1924x1556px. 200° field of view. UWF retinal mosaic.
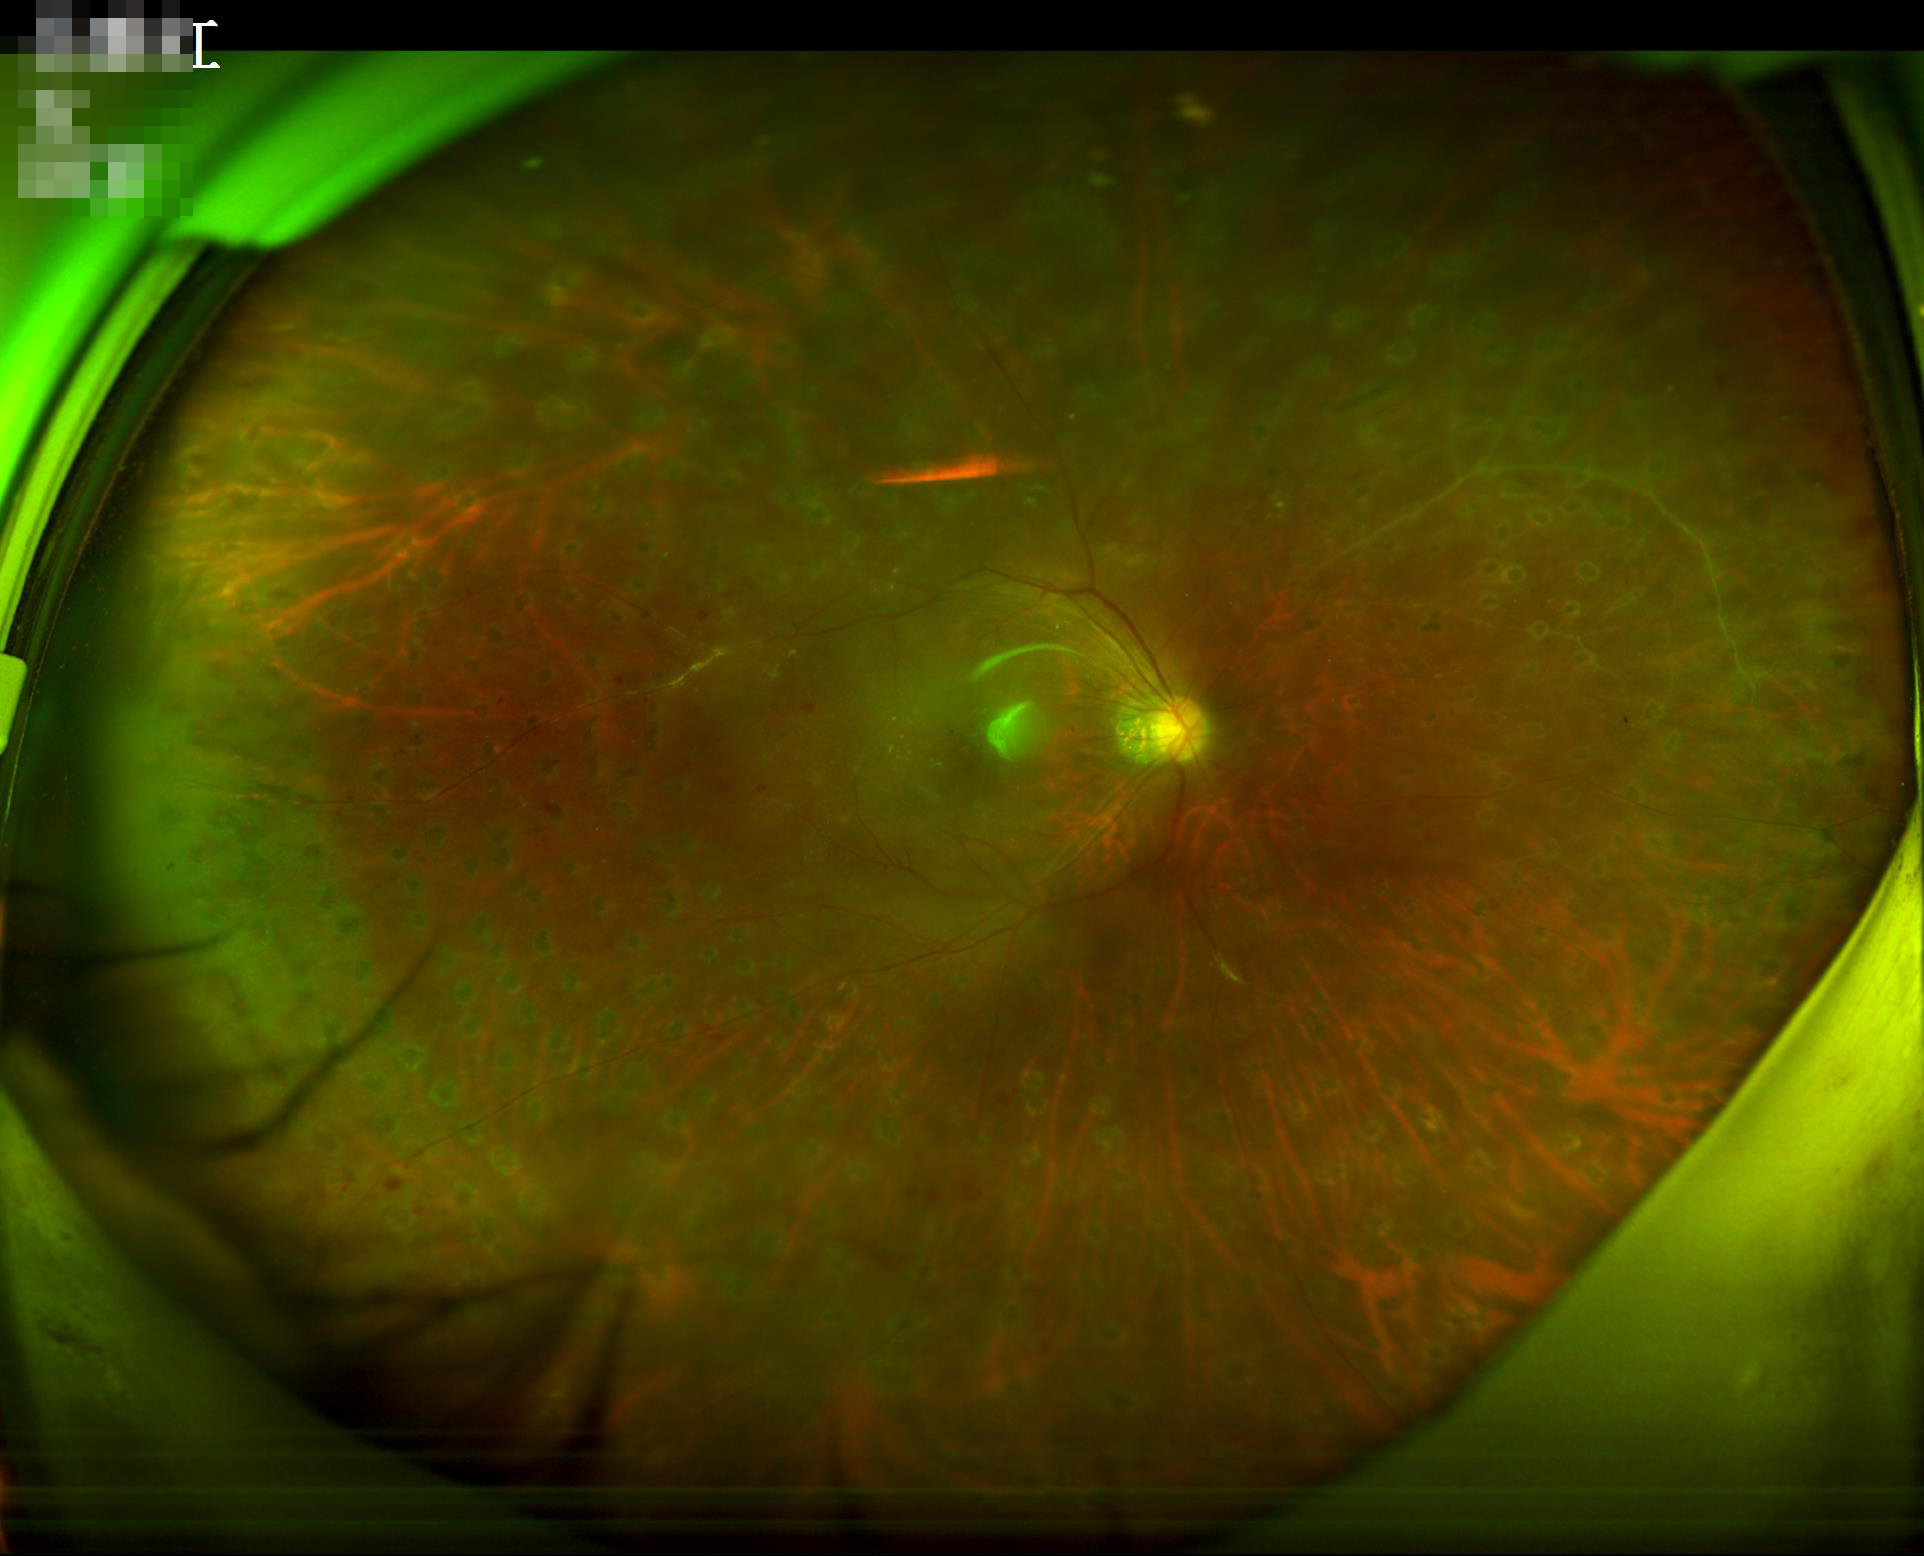

Image quality: contrast: low, vessels and details hard to distinguish | illumination: good illumination and color balance | overall: poor, ungradable | sharpness: optic disc, vessels, and background in focus.